45° FOV.
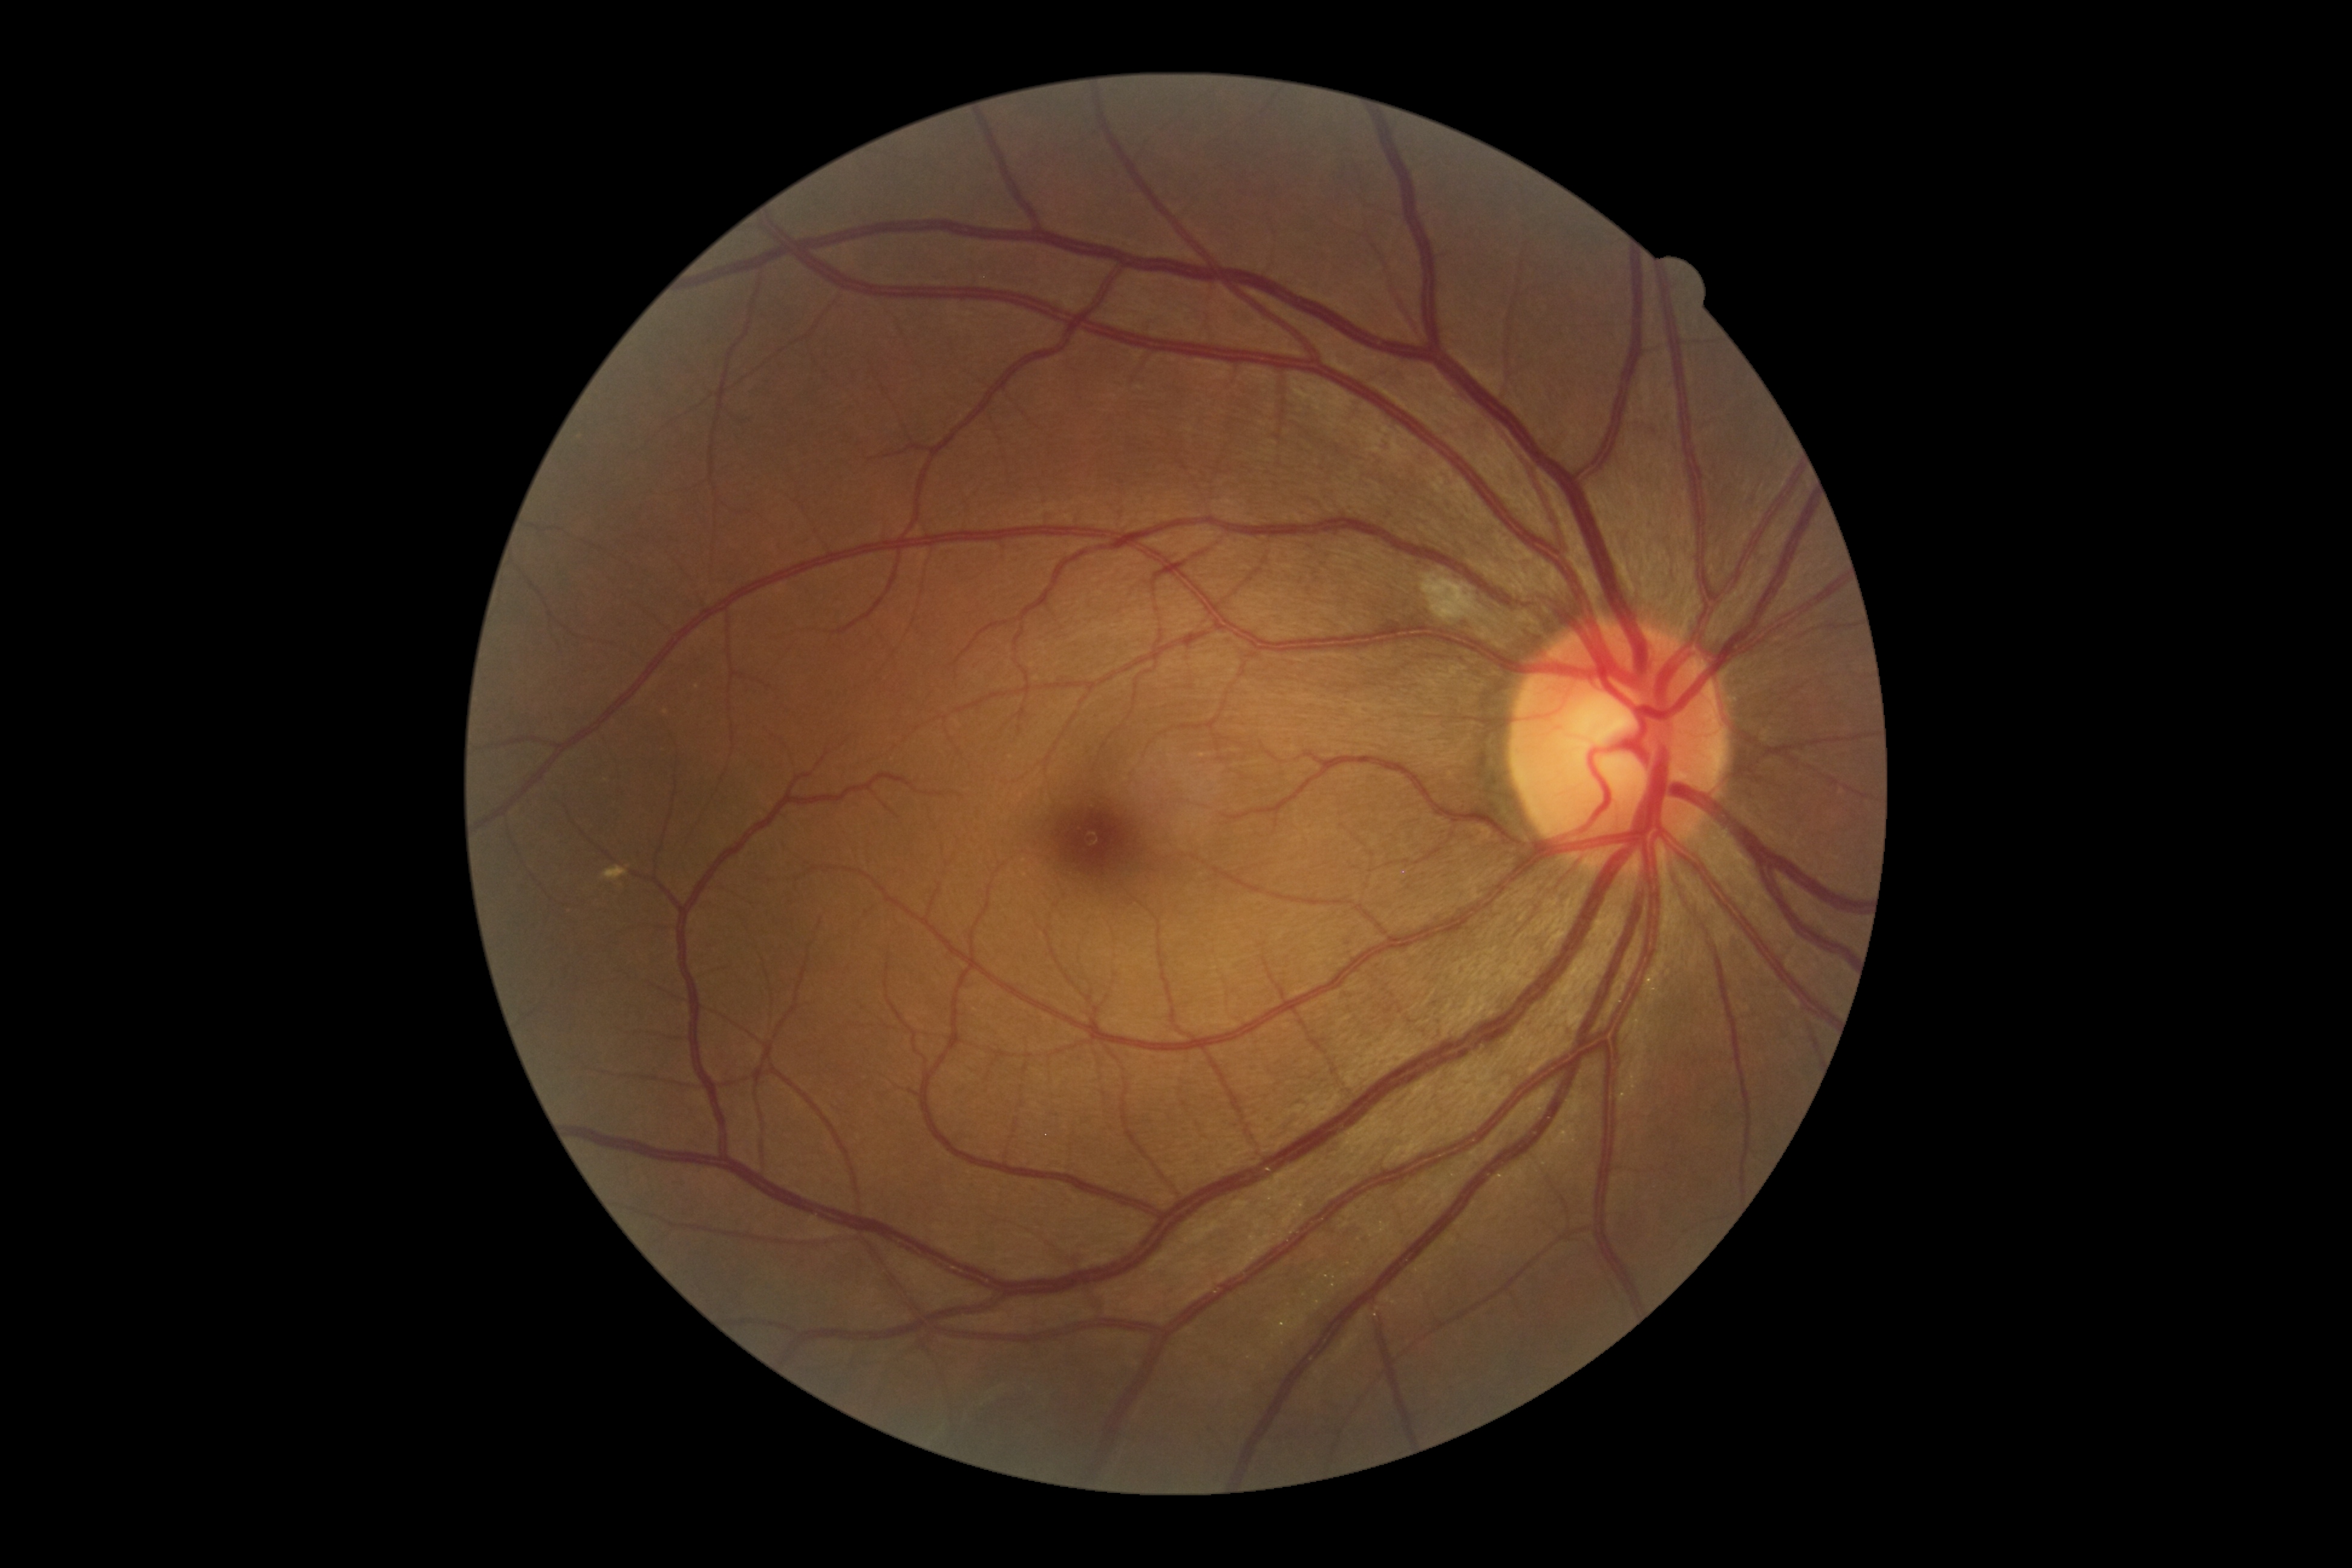 Disease class: non-proliferative diabetic retinopathy.
Diabetic retinopathy (DR): 2 — more than just microaneurysms but less than severe NPDR.